45° field of view — 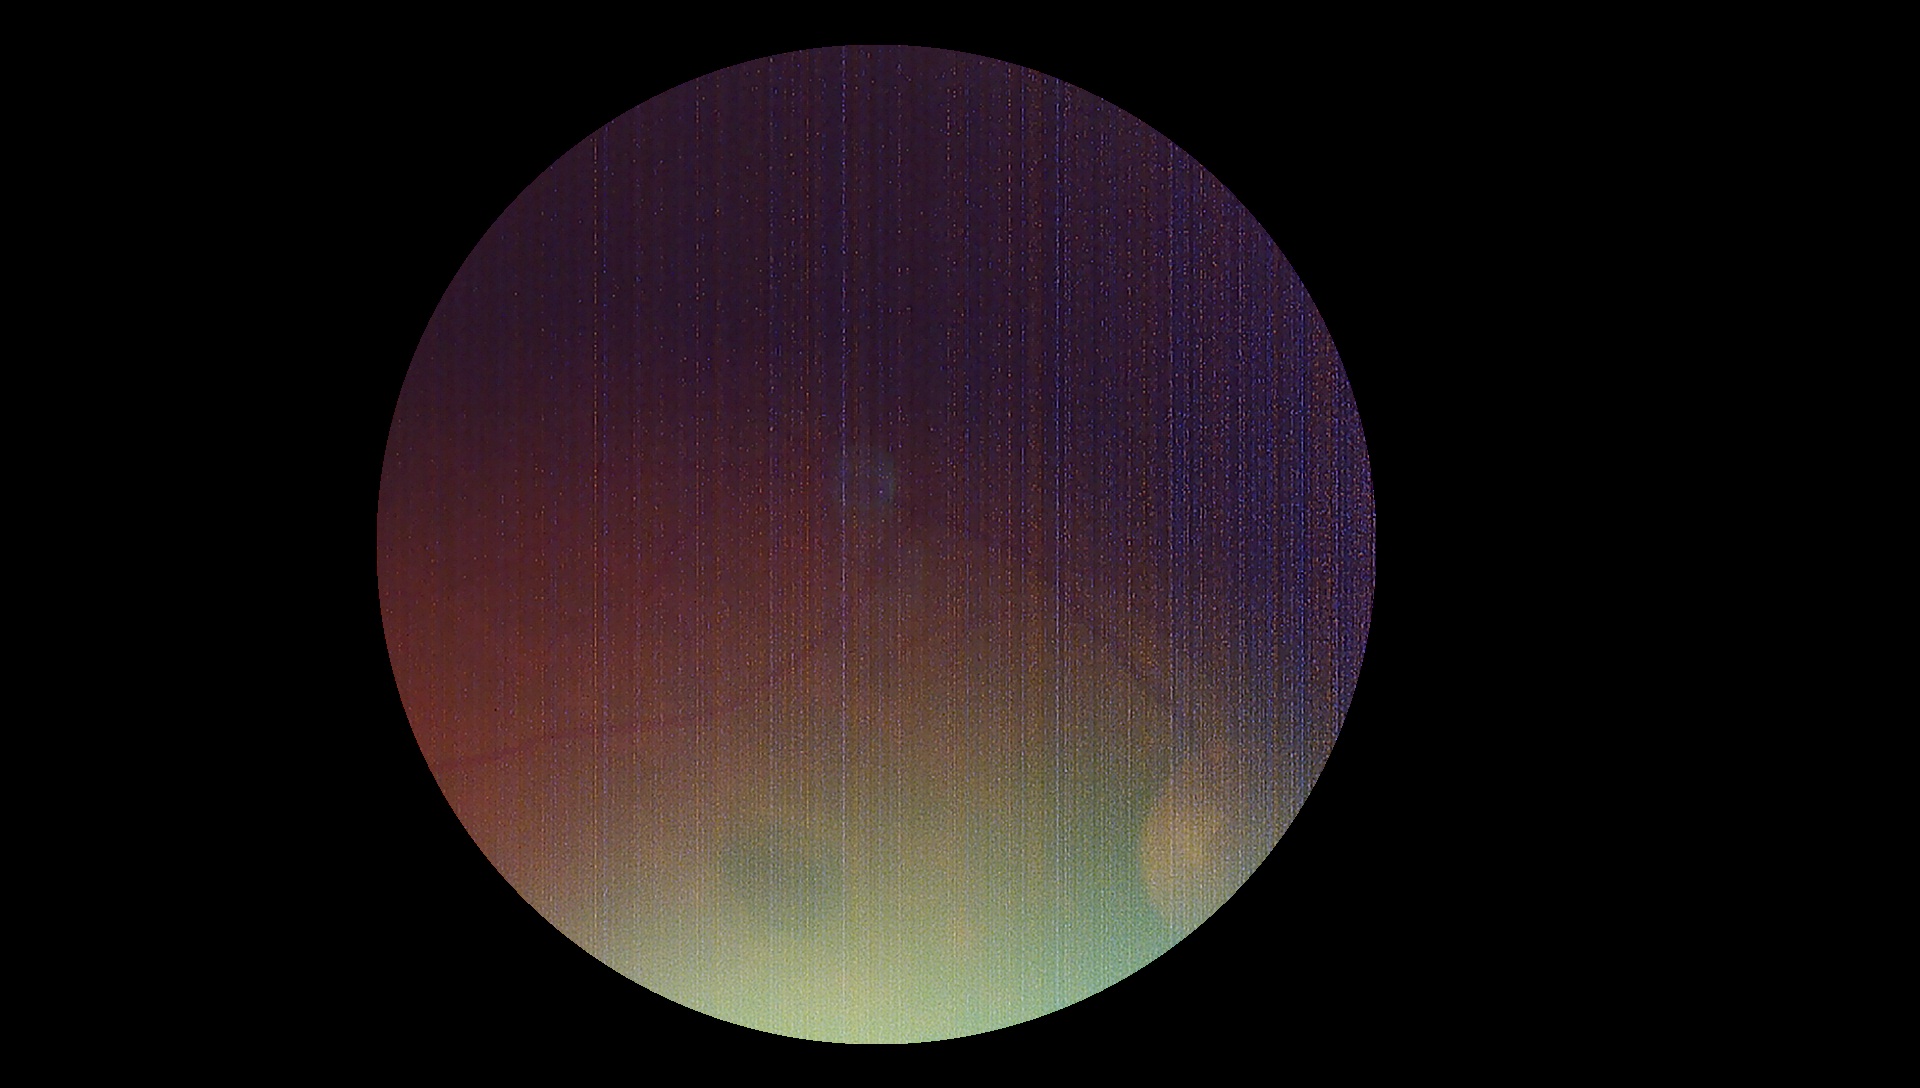
DR: ungradable due to poor image quality.
Ungradable image — DR severity cannot be determined.